45-degree field of view
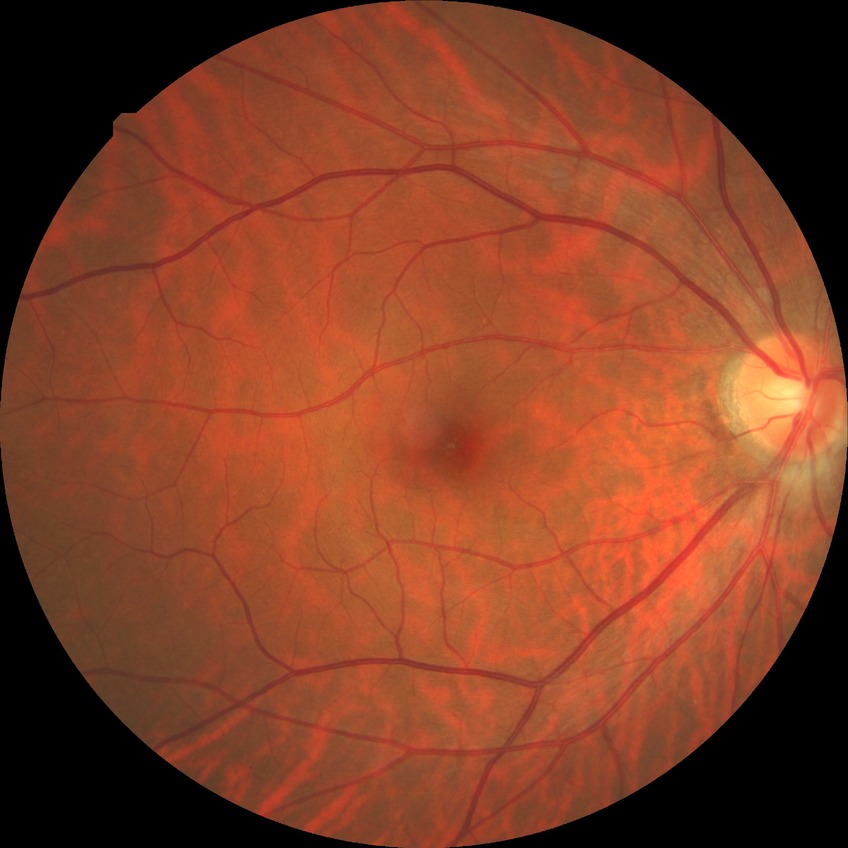
Modified Davis grading is no diabetic retinopathy.